848 by 848 pixels; CFP
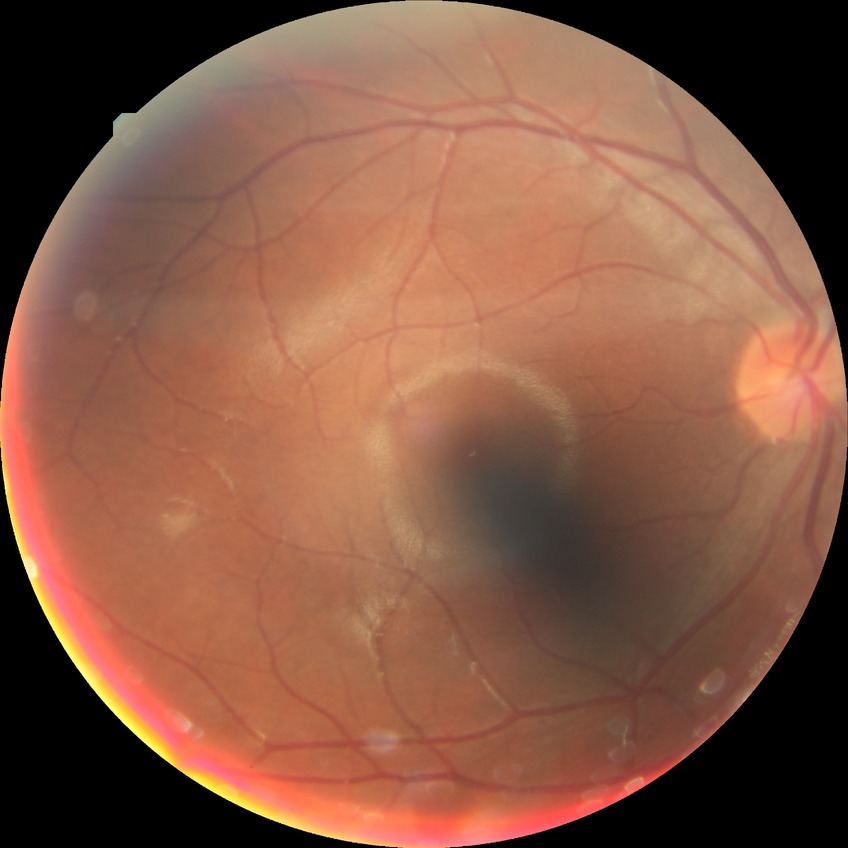 Retinopathy grade is no diabetic retinopathy.